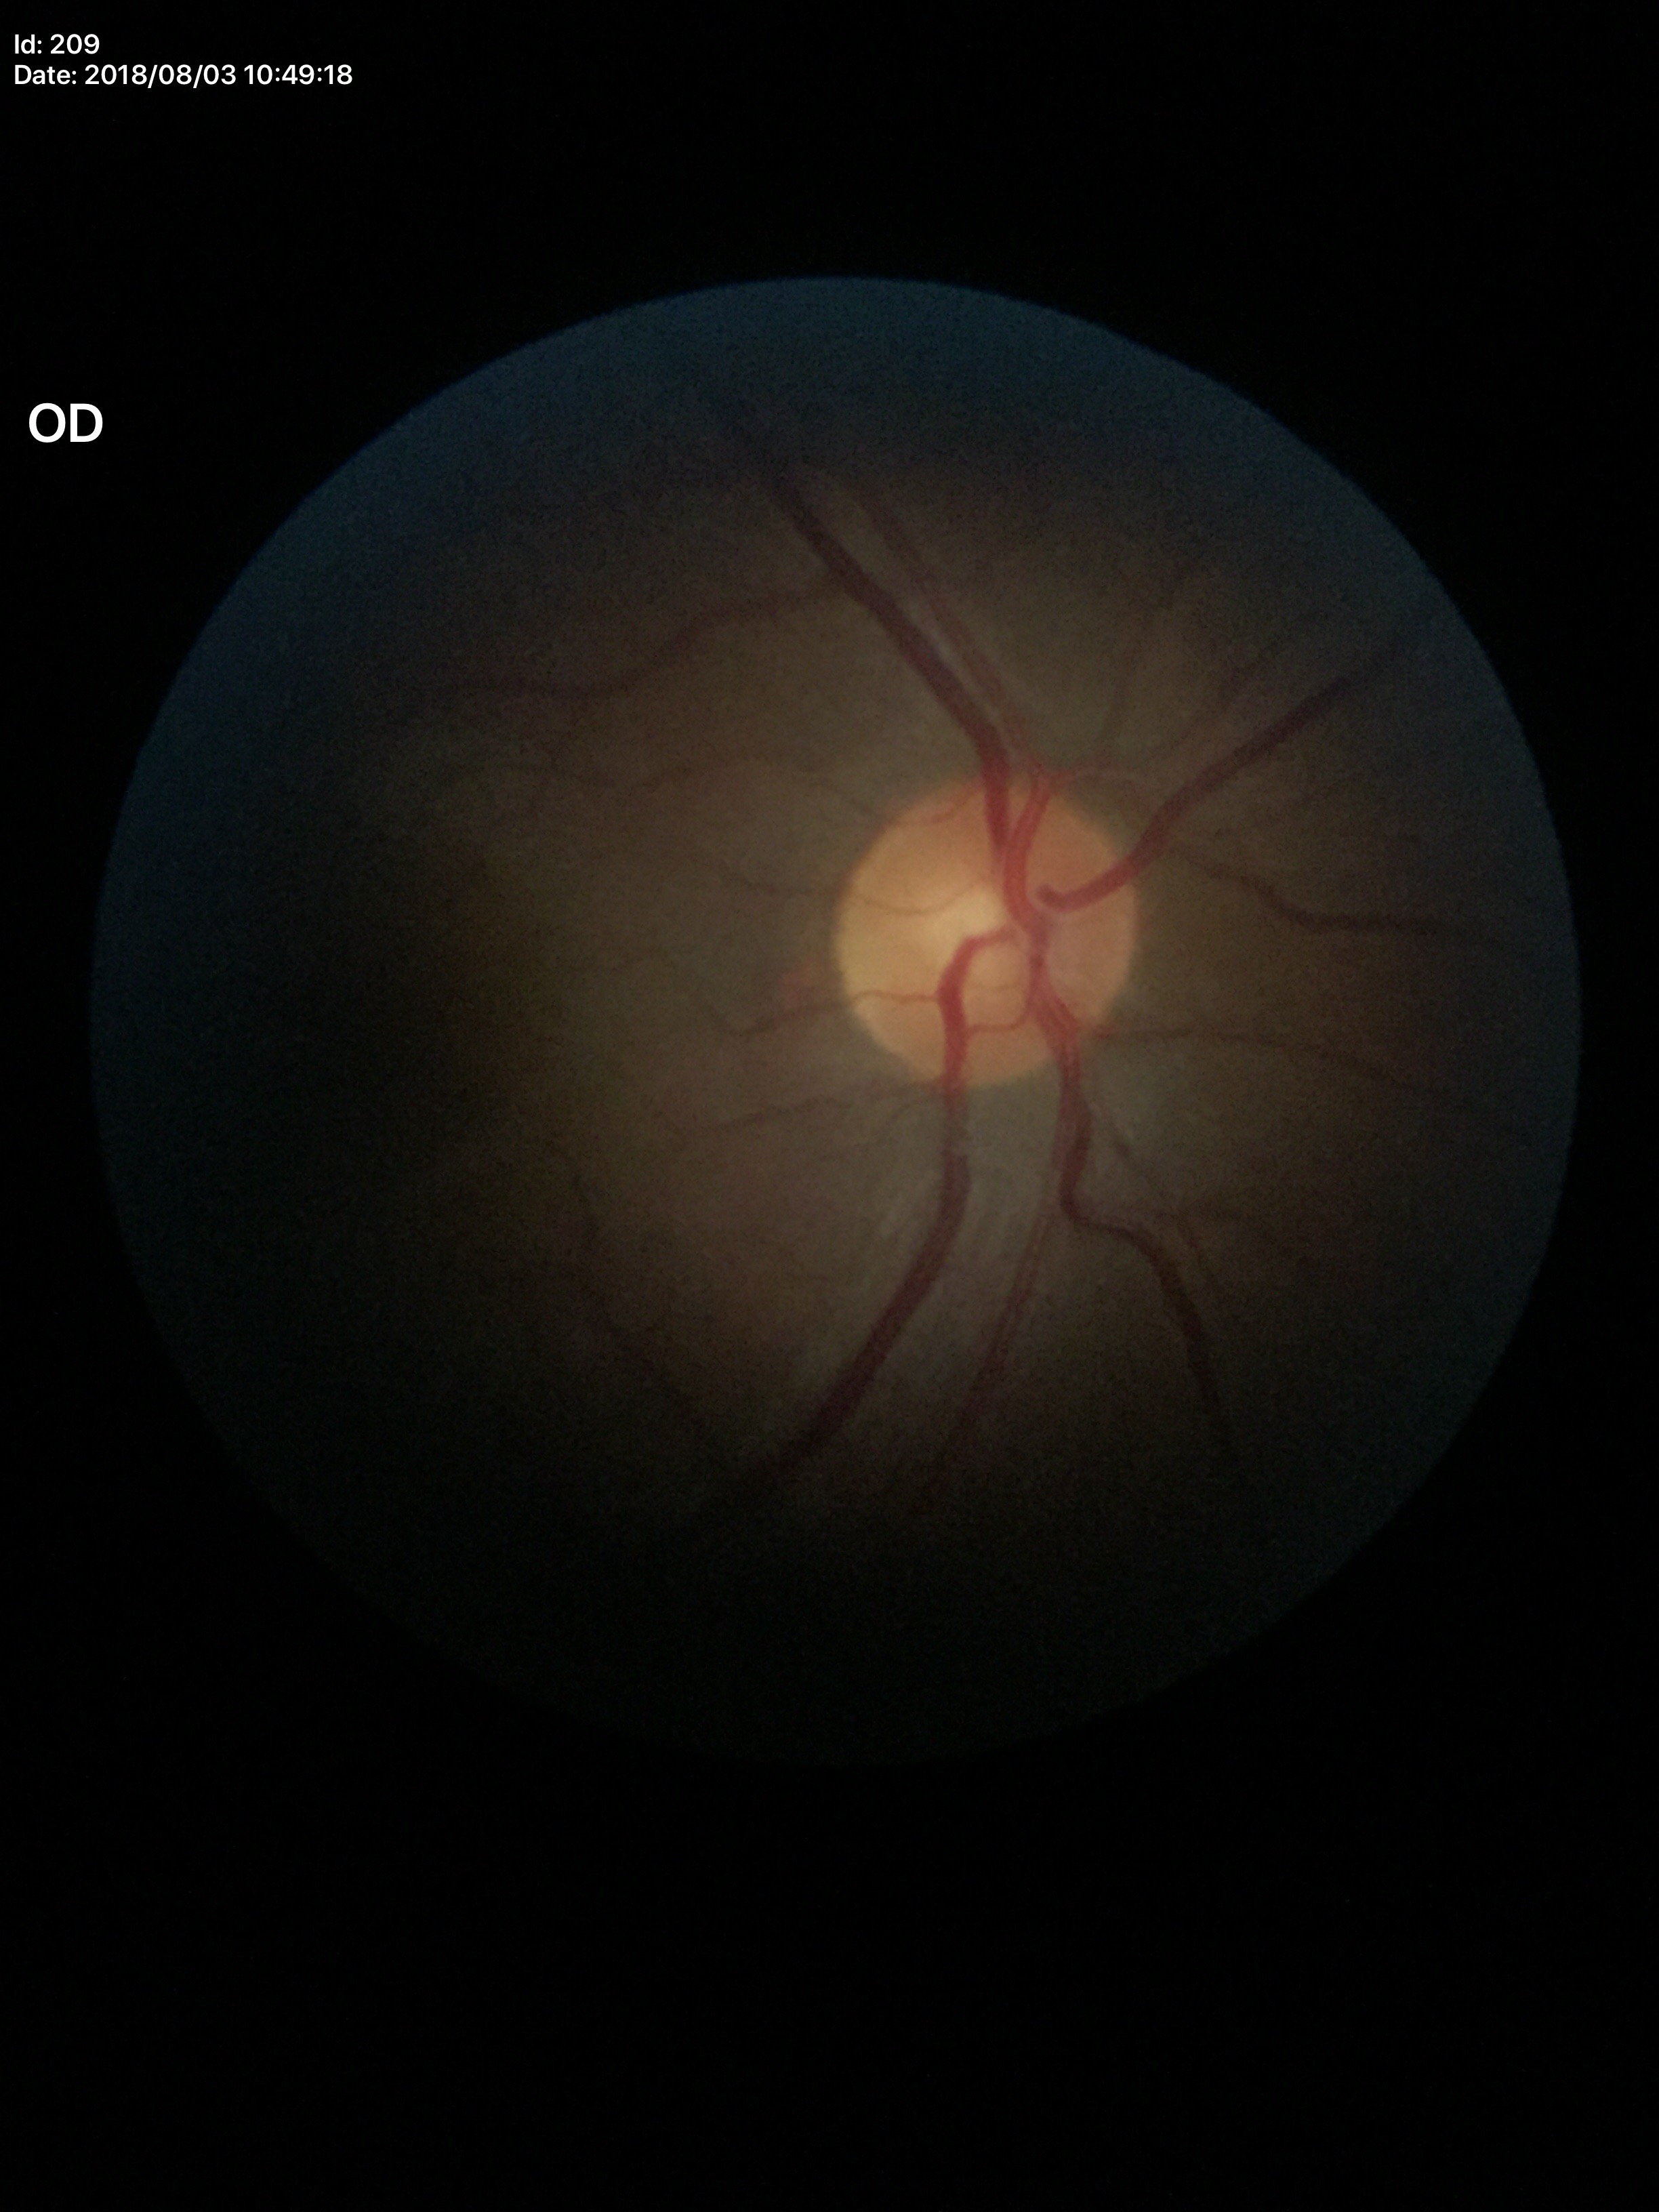

glaucoma_decision: no suspicious findings (all 5 graders called normal)
vcdr: 0.41